Color fundus photograph:
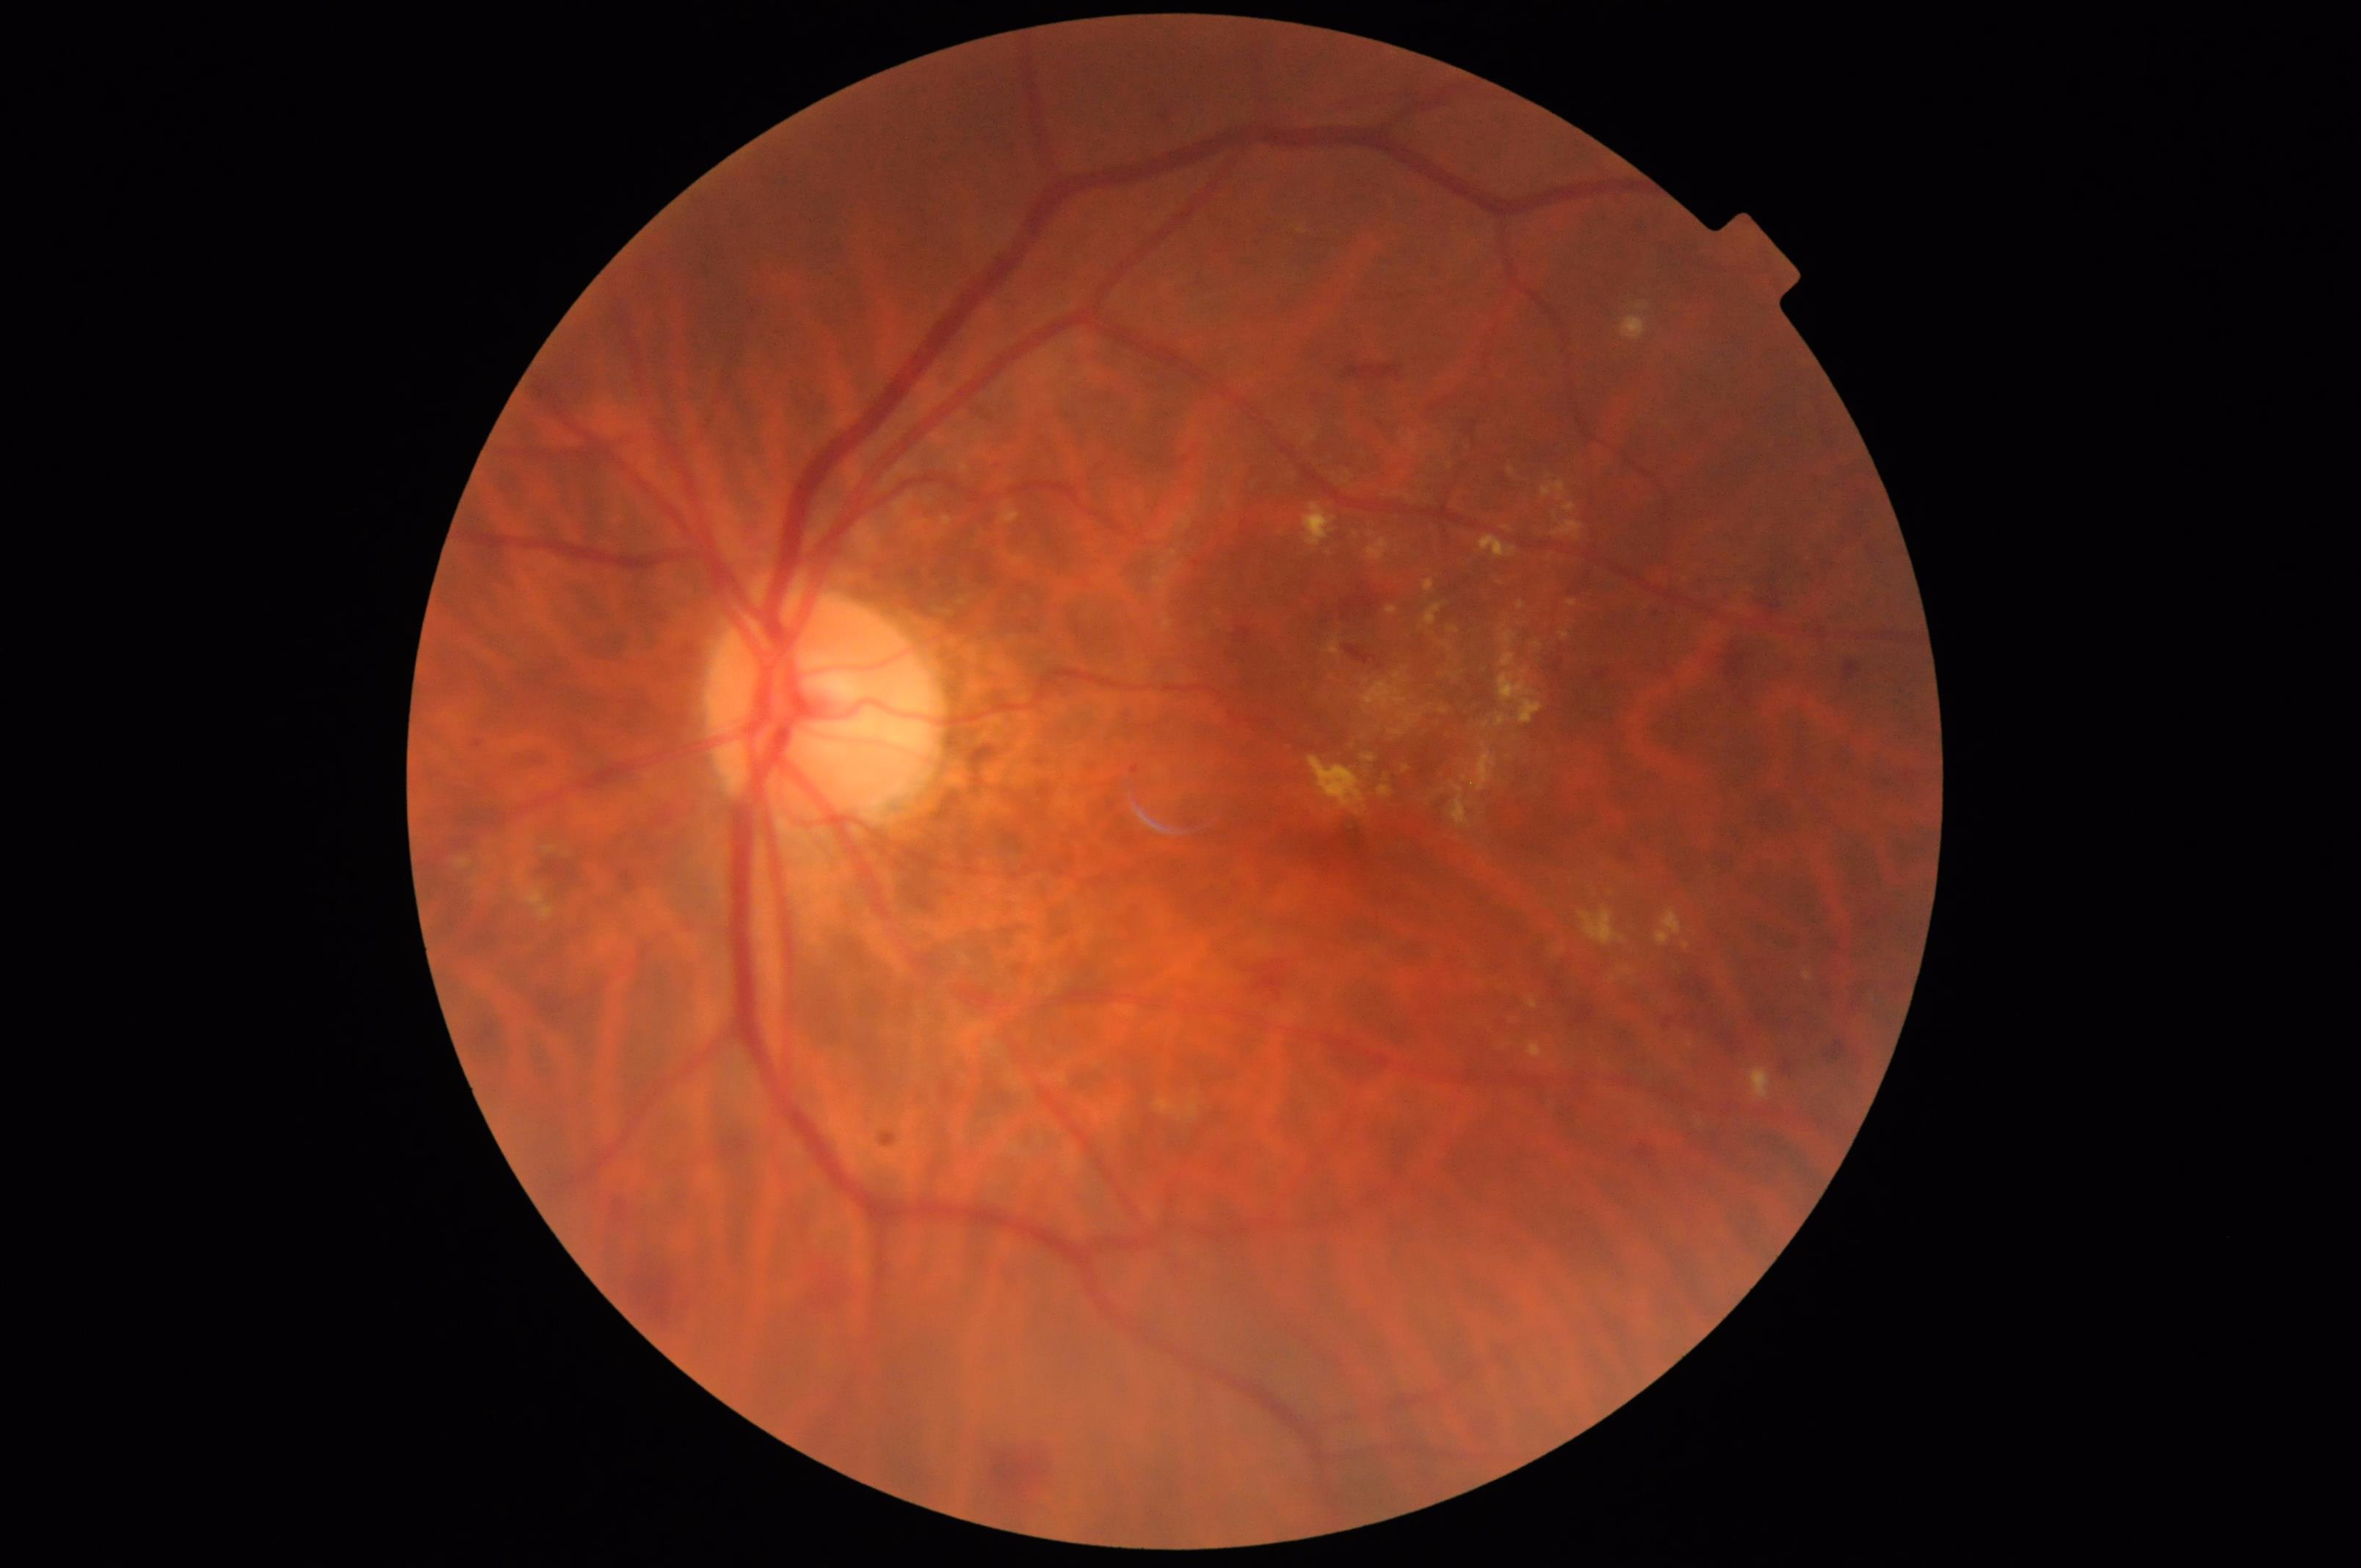   illumination: no over- or under-exposure
  contrast: vessels and details readily distinguishable
  overall_quality: good, gradable
  clarity: clear with no noticeable blur